Color fundus photograph · 512 by 512 pixels:
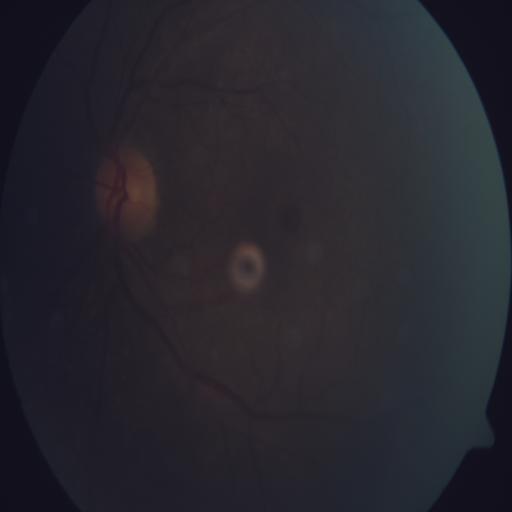

Impression: macular hole.